Acquired with a Canon CR-1 · color fundus image: 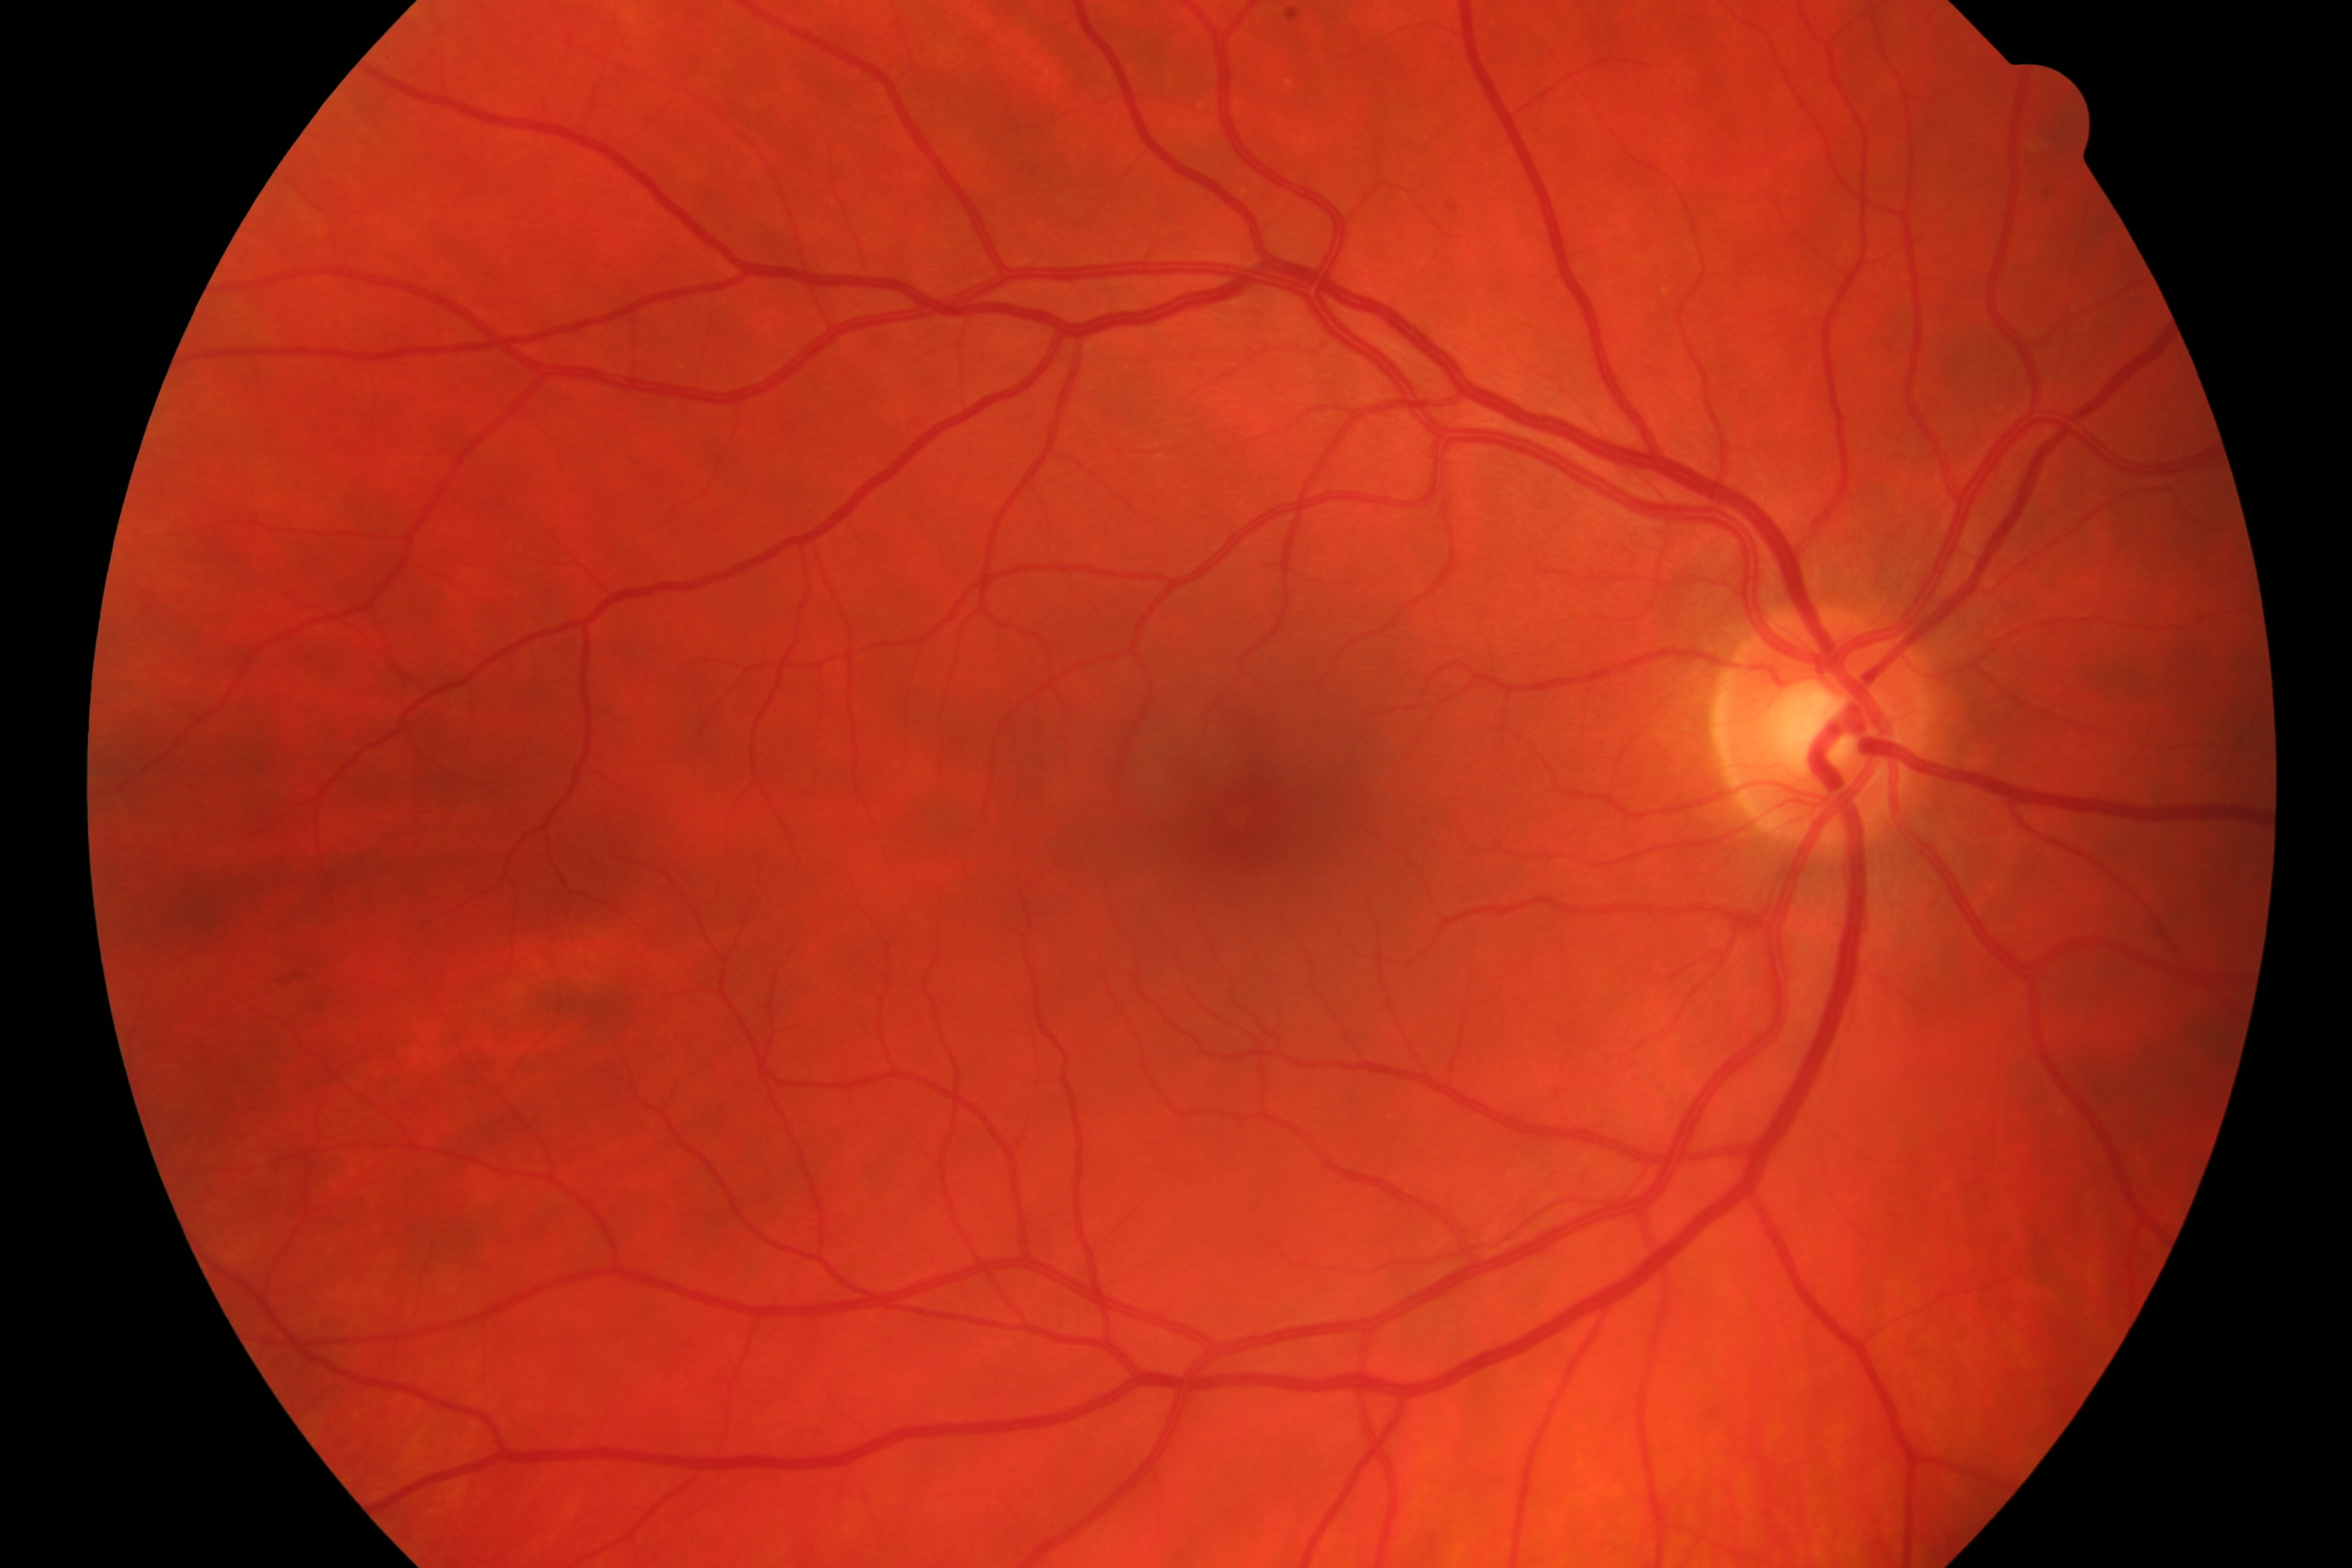
Findings consistent with glaucoma.